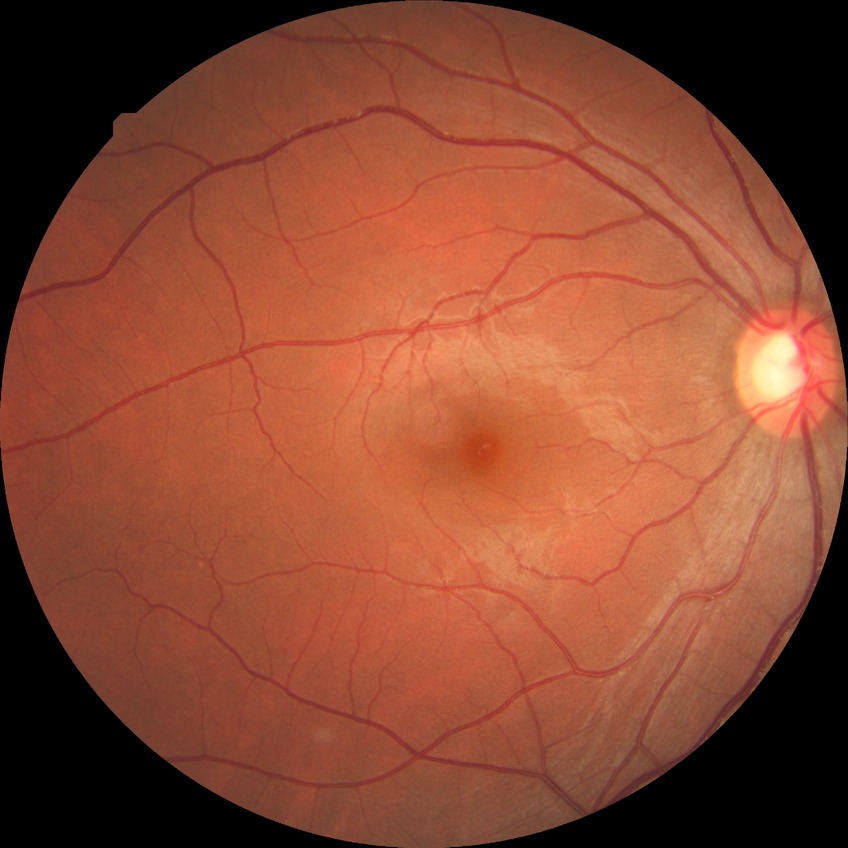 {
  "davis_grade": "no diabetic retinopathy (NDR)"
}